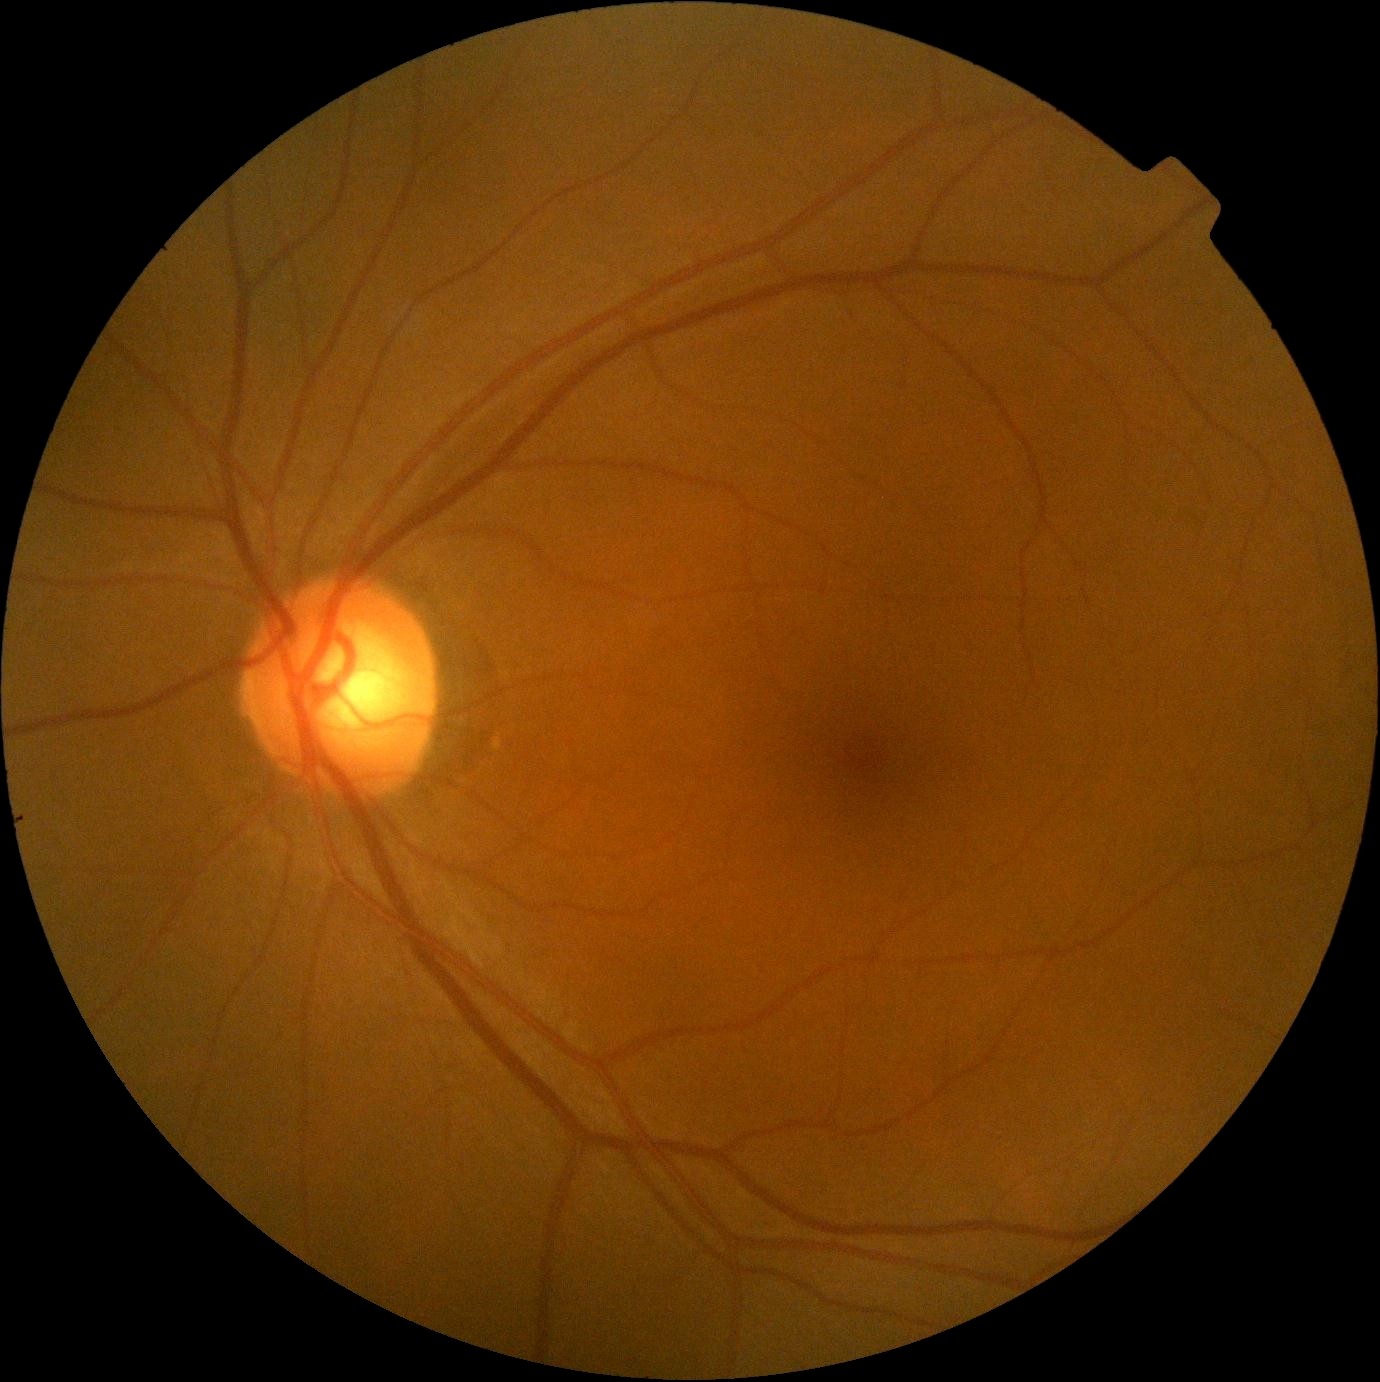
Diabetic retinopathy grade: 0/4.